Pediatric retinal photograph (wide-field).
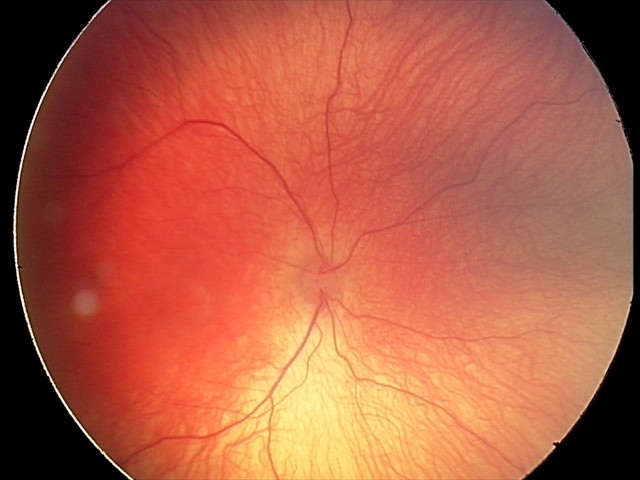

Q: Plus disease status?
A: no plus disease
Q: What is the screening diagnosis?
A: ROP stage 1